Graded on the modified Davis scale:
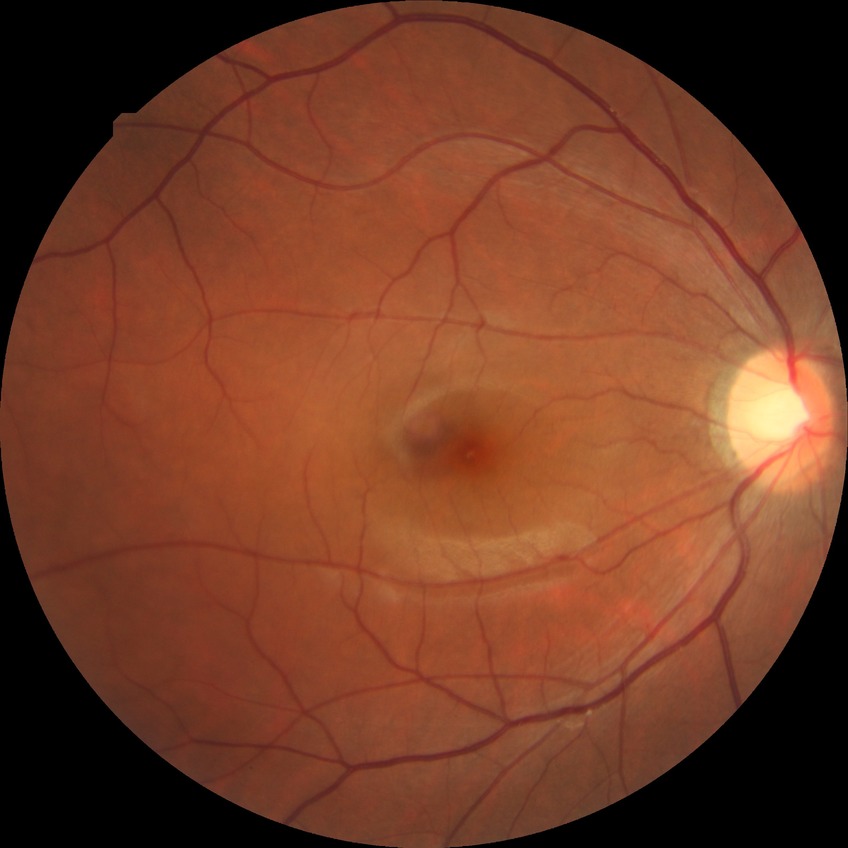
diabetic retinopathy (DR)=NDR (no diabetic retinopathy).